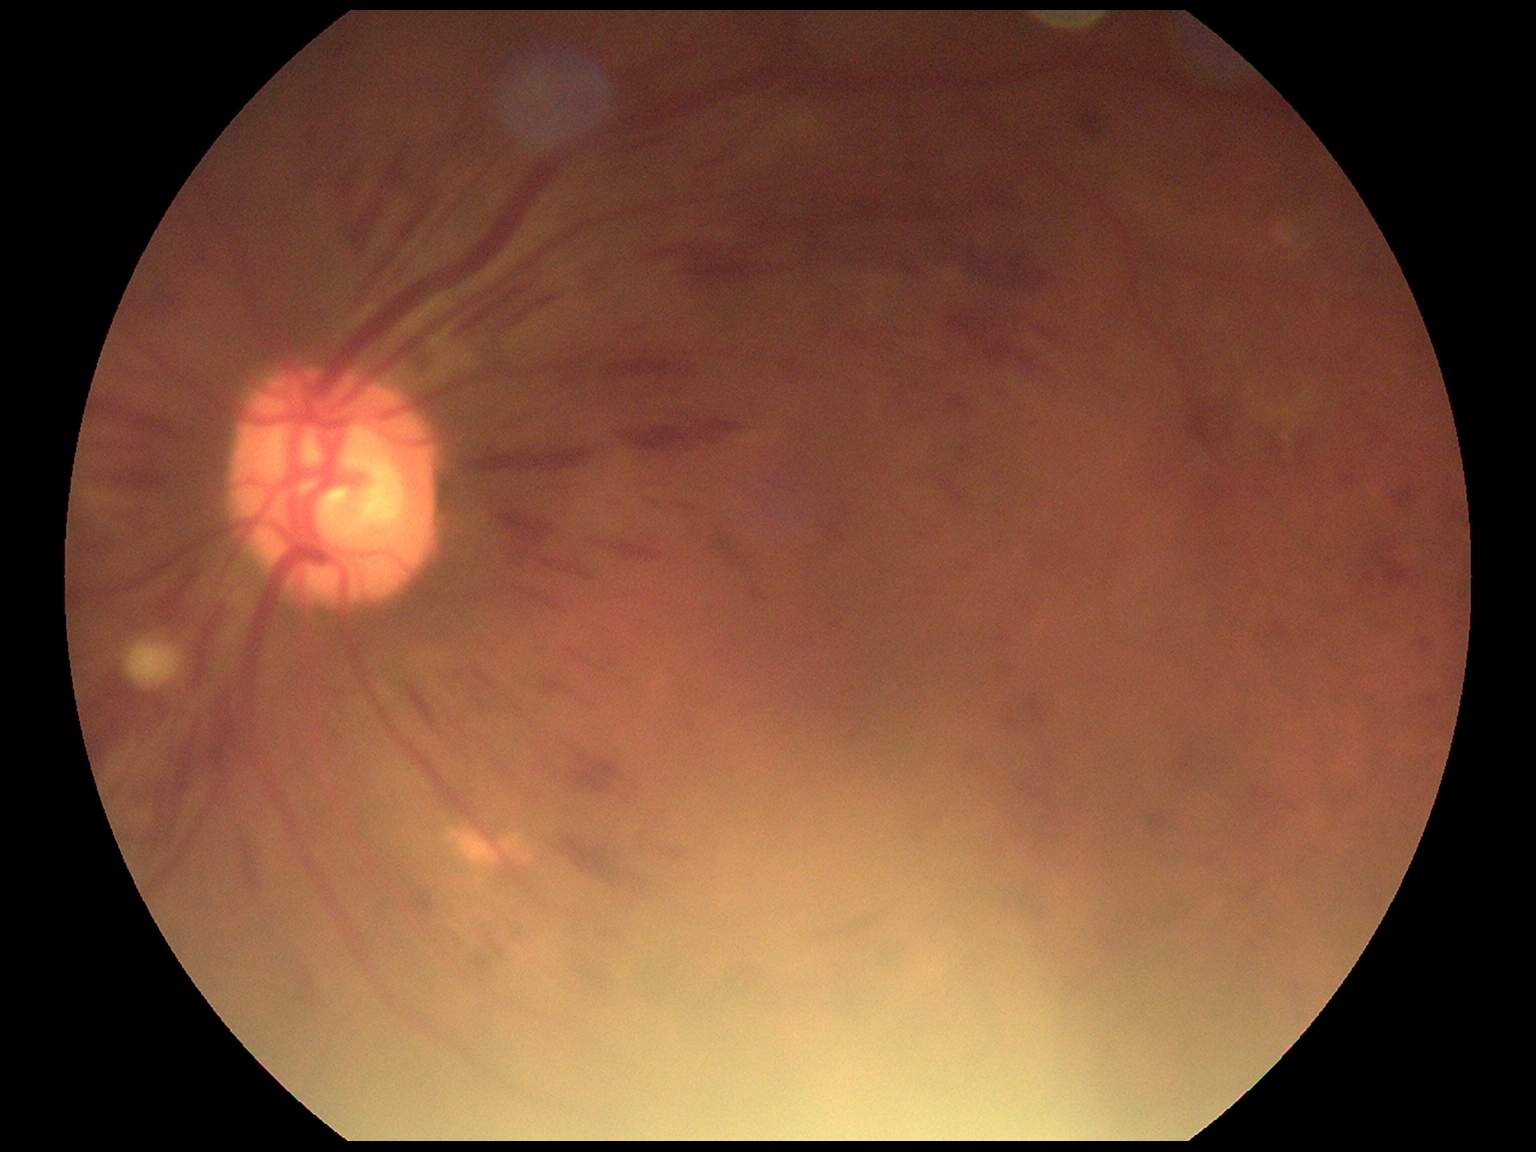 DR is grade 3 (severe NPDR).